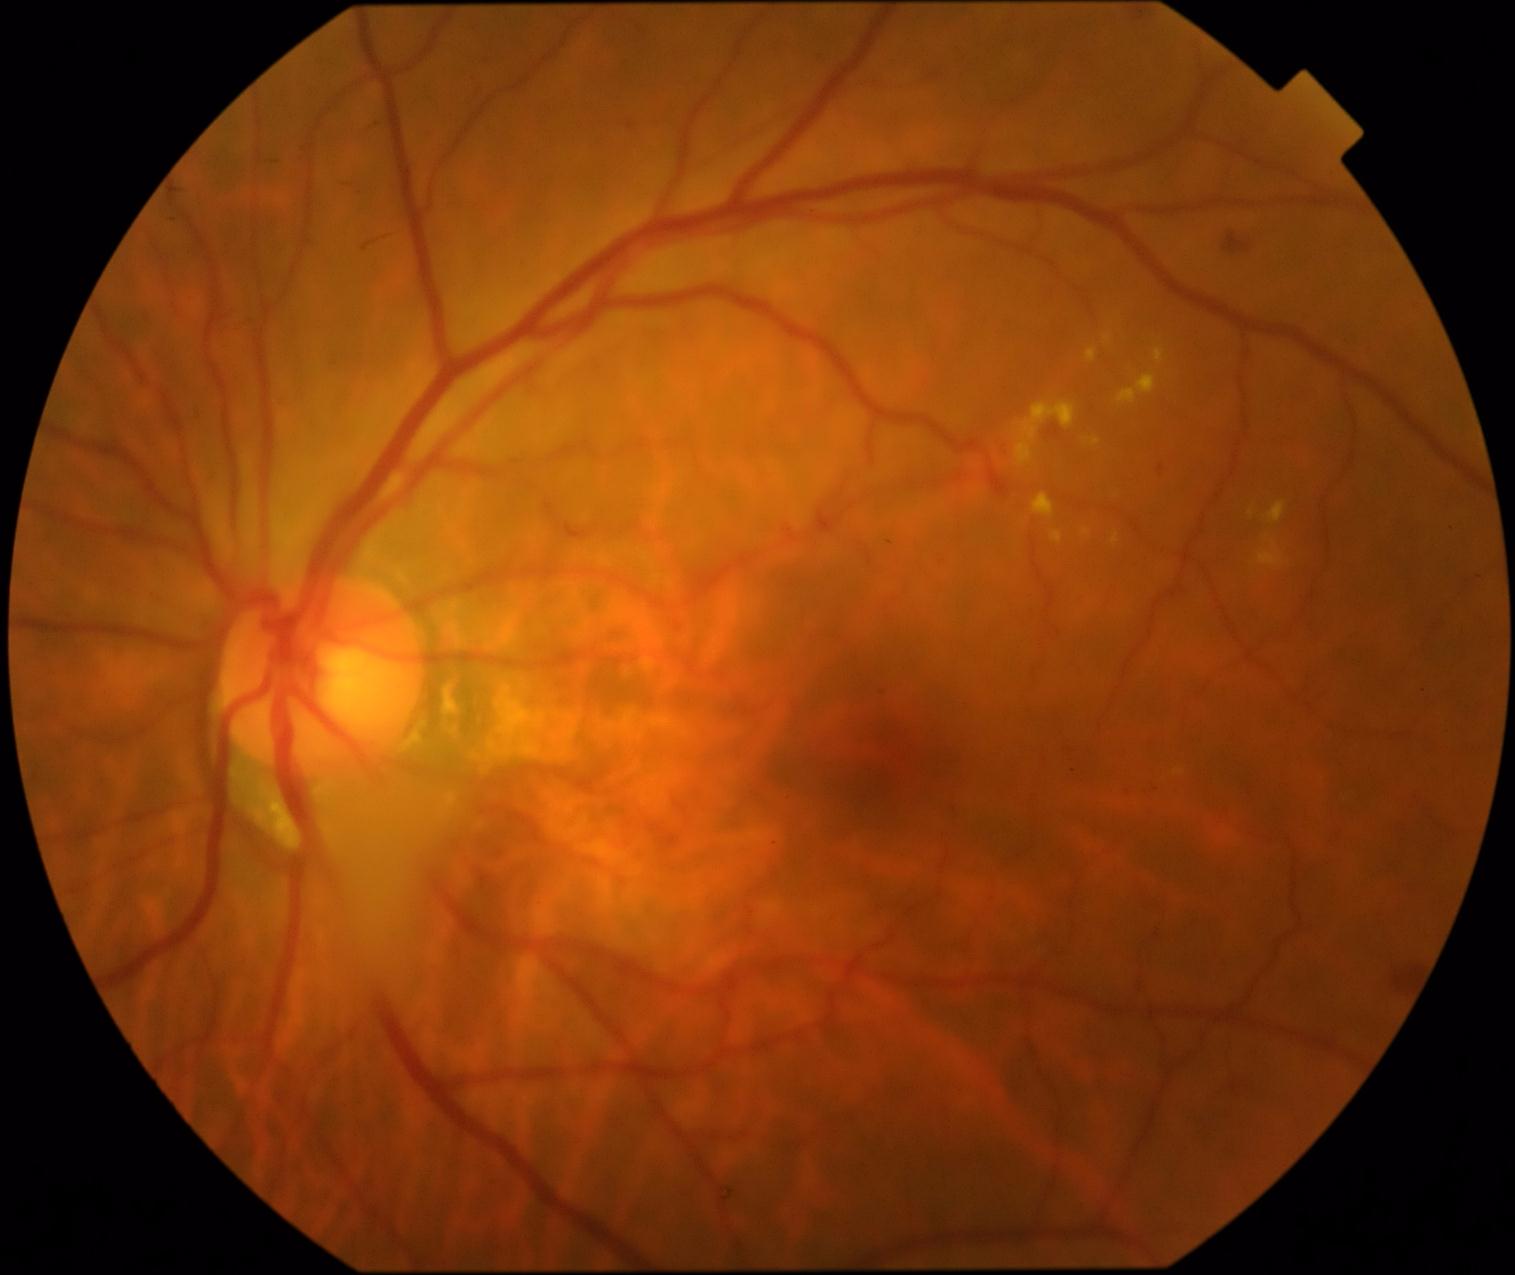 Findings:
– DR grade: 2